Captured with the Natus RetCam Envision (130° field of view); pediatric retinal photograph (wide-field): 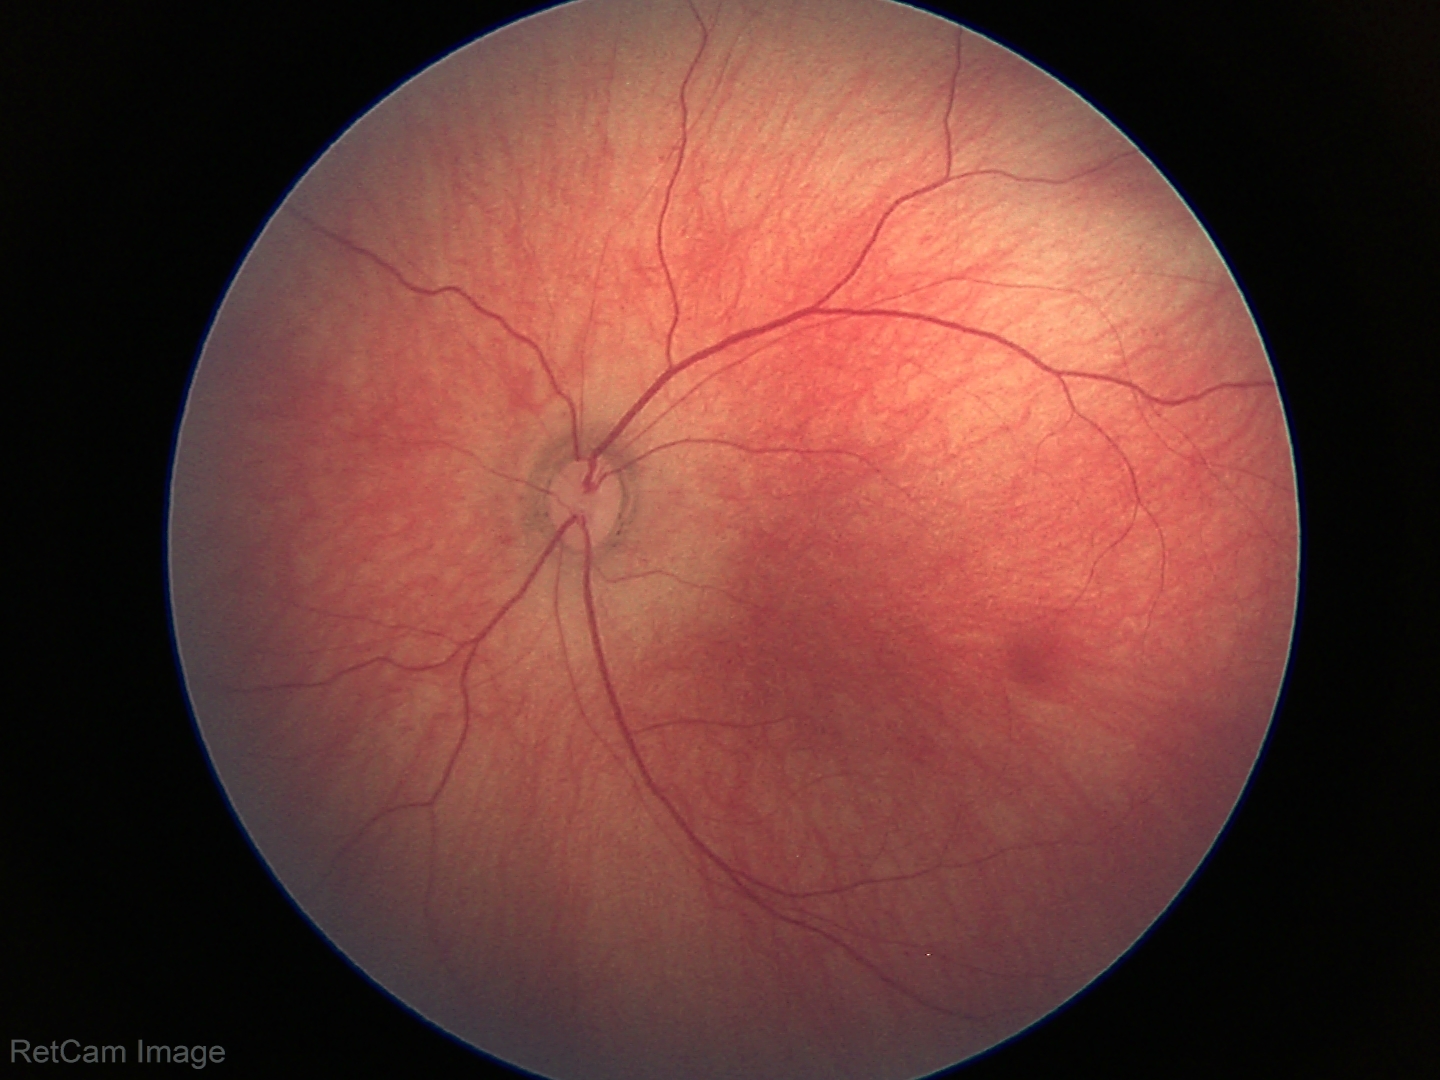 Screening diagnosis: normal fundus examination.